FOV: 45 degrees: 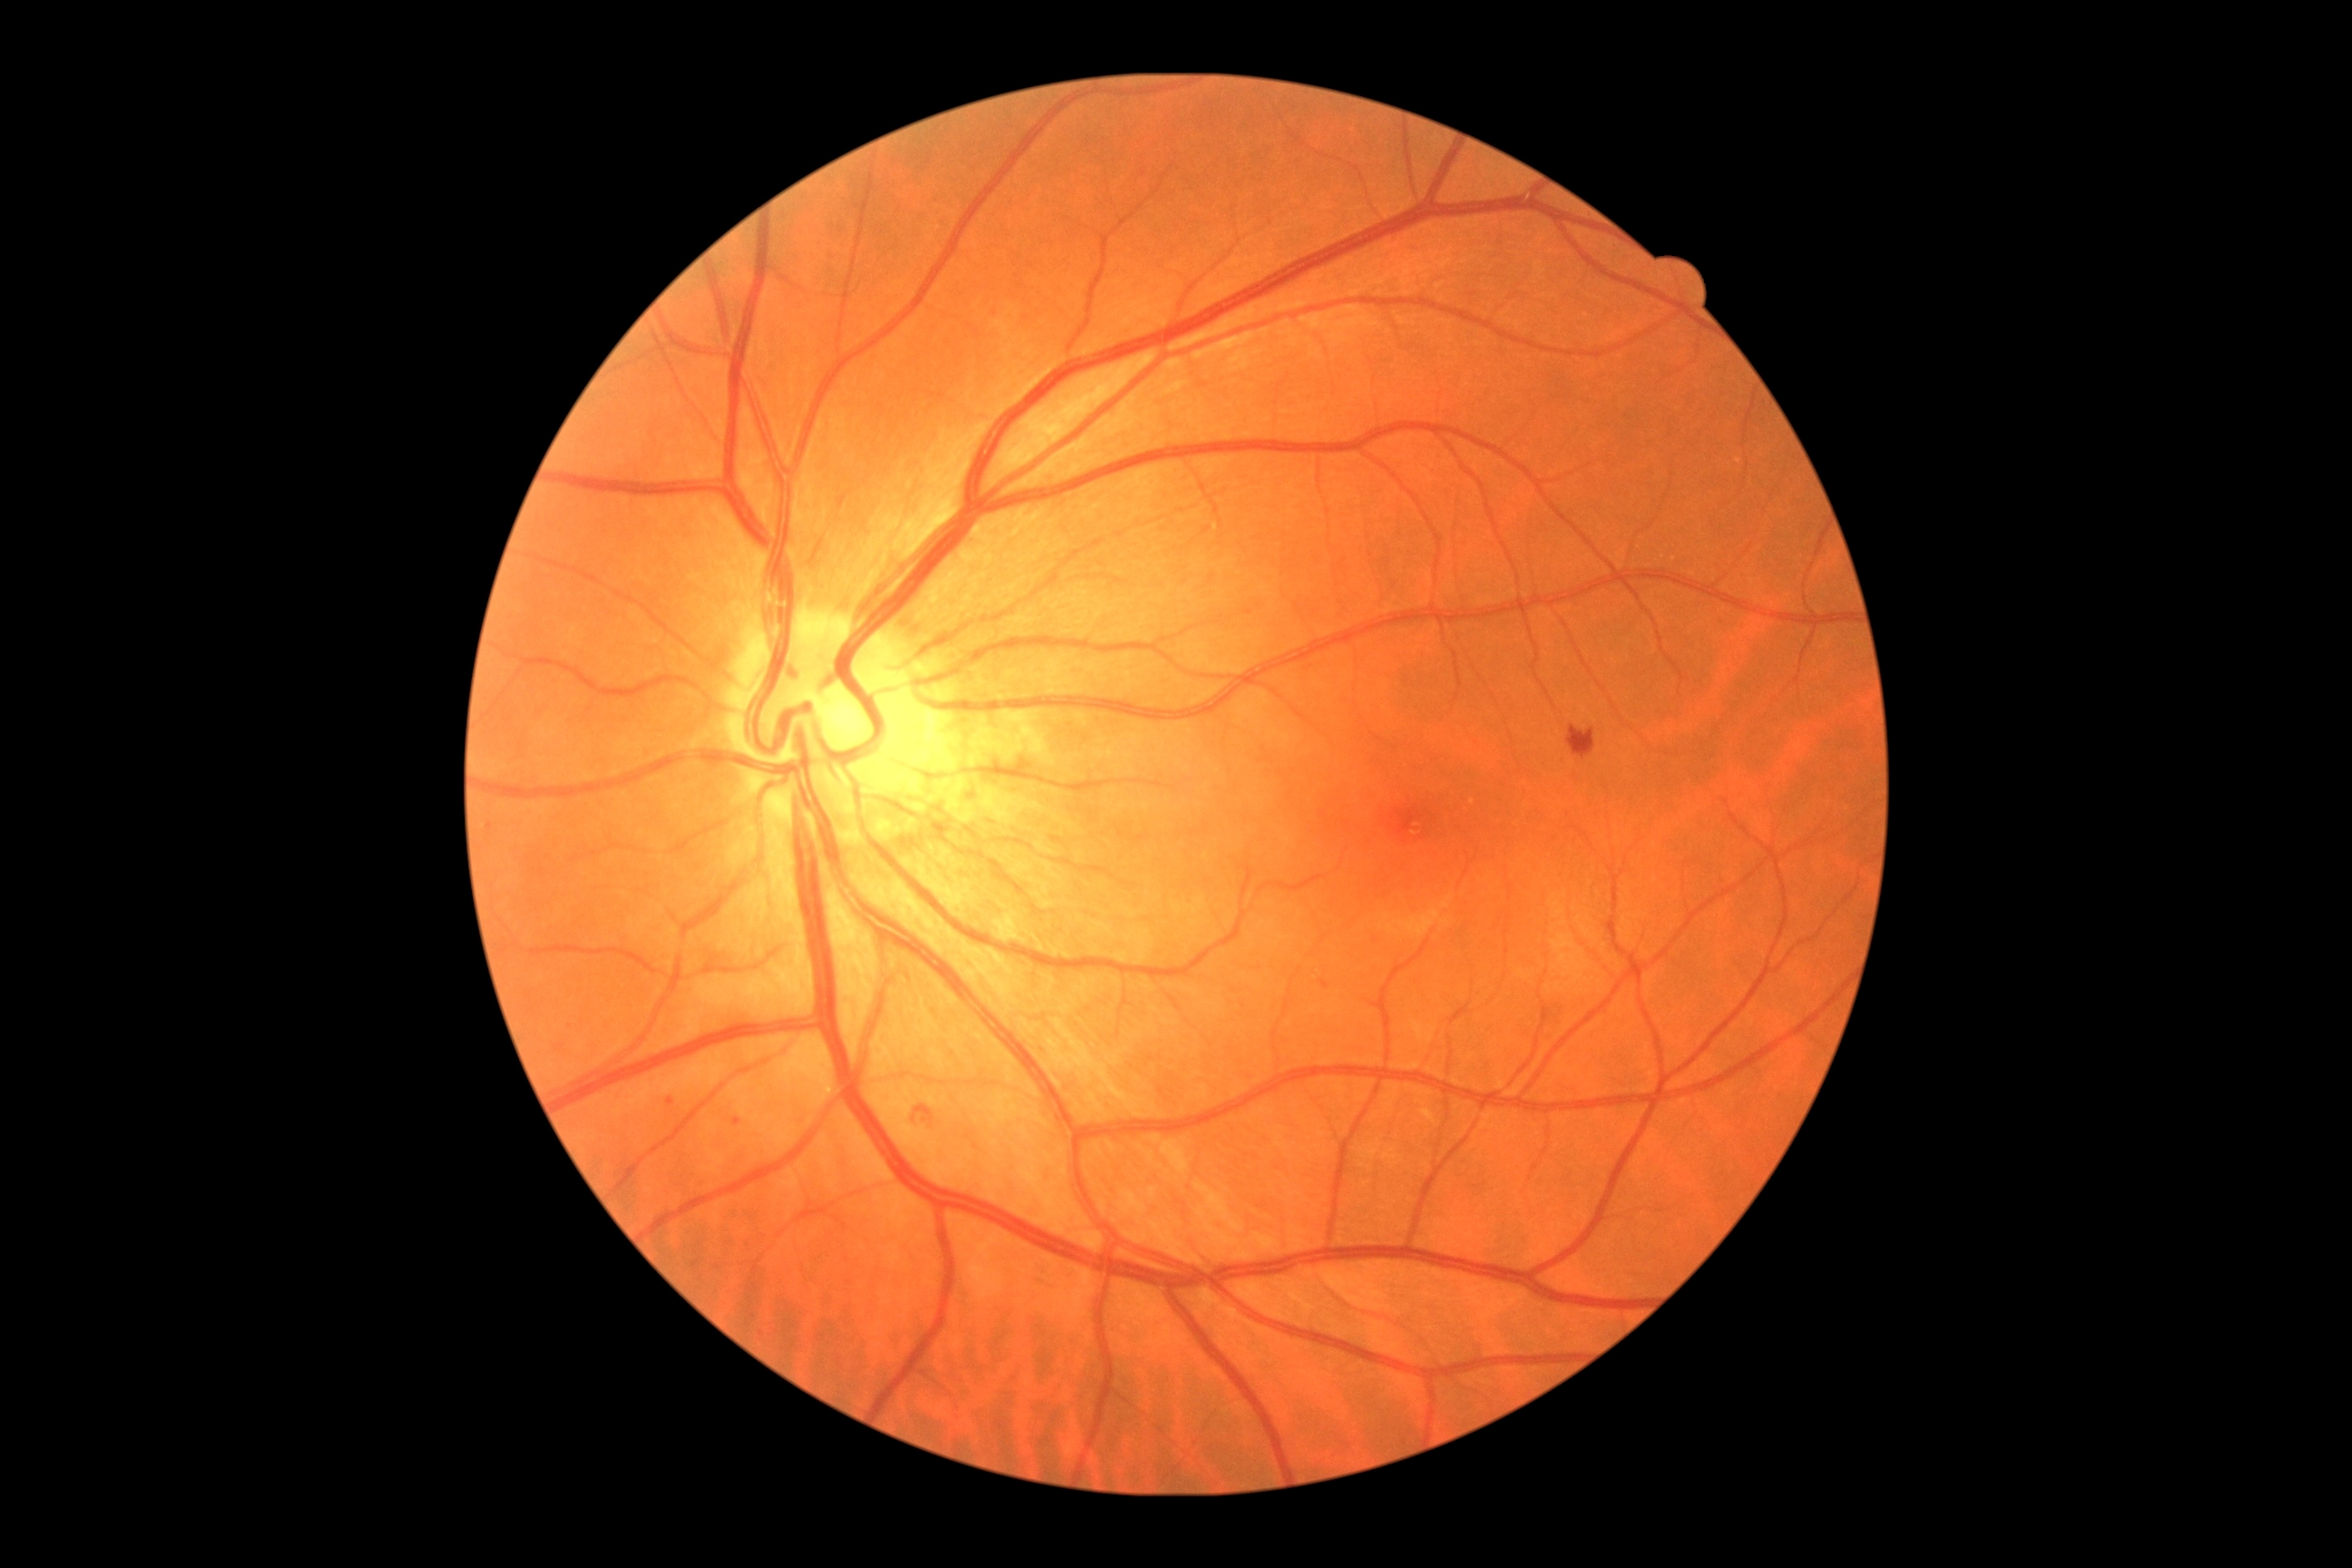
Diabetic retinopathy (DR) is grade 2
A subset of detected lesions:
soft exudates (SEs): not present
hemorrhages (HEs): {"x1": 912, "y1": 1106, "x2": 934, "y2": 1124} | {"x1": 1567, "y1": 727, "x2": 1596, "y2": 758}
hard exudates (EXs): not present
microaneurysms (MAs) (subset): {"x1": 1320, "y1": 979, "x2": 1329, "y2": 990} | {"x1": 732, "y1": 1117, "x2": 743, "y2": 1126}
Small MAs near (x=490, y=826) | (x=670, y=1101) | (x=753, y=1316)